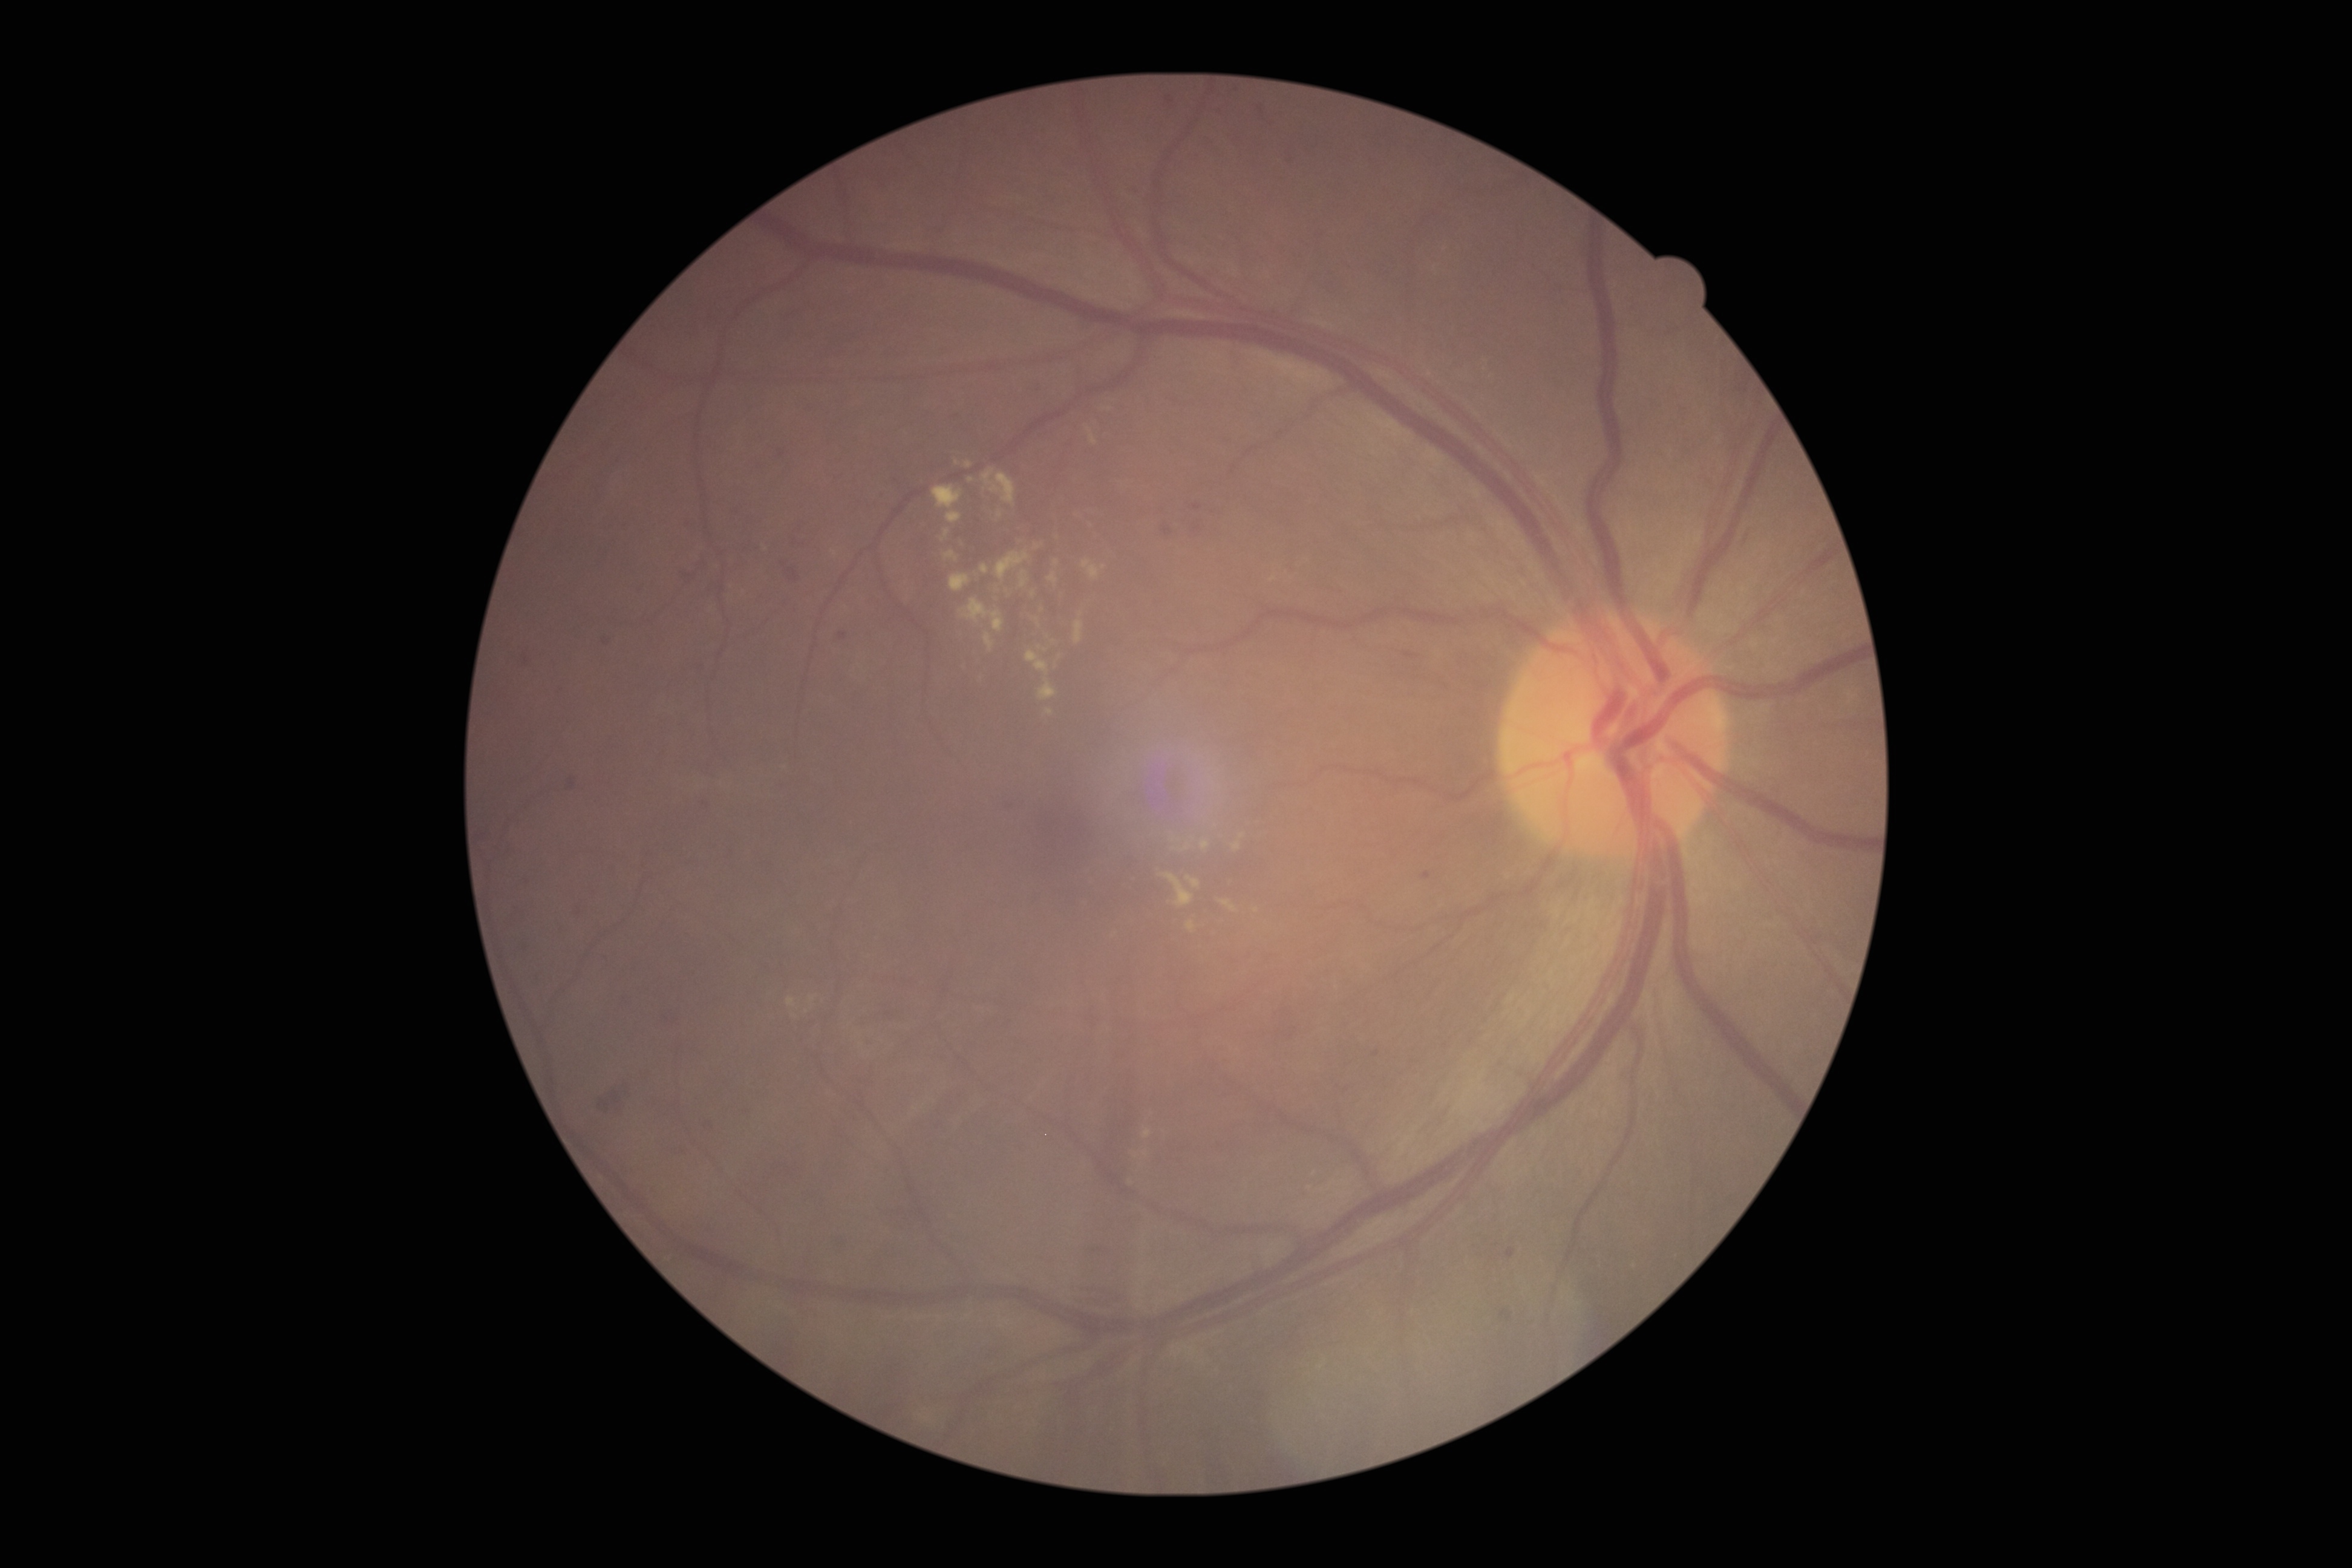

DR: moderate NPDR (grade 2)
Lesions identified (partial list):
MAs (more not shown) = [x1=704, y1=1121, x2=714, y2=1131] | [x1=486, y1=901, x2=492, y2=916] | [x1=477, y1=831, x2=487, y2=845] | [x1=1186, y1=501, x2=1204, y2=514] | [x1=792, y1=539, x2=806, y2=547] | [x1=1005, y1=803, x2=1014, y2=810] | [x1=780, y1=561, x2=800, y2=584] | [x1=1504, y1=1248, x2=1517, y2=1260] | [x1=777, y1=449, x2=787, y2=459] | [x1=1161, y1=523, x2=1174, y2=538] | [x1=577, y1=907, x2=583, y2=916] | [x1=1500, y1=1310, x2=1513, y2=1323]
Smaller MAs around <pt>525,949</pt> | <pt>1220,1147</pt> | <pt>1221,114</pt> | <pt>688,525</pt>
HEs (more not shown) = [x1=699, y1=562, x2=707, y2=570] | [x1=855, y1=1091, x2=866, y2=1112] | [x1=1402, y1=653, x2=1421, y2=660] | [x1=1088, y1=1247, x2=1111, y2=1256] | [x1=1277, y1=1028, x2=1298, y2=1042] | [x1=681, y1=573, x2=697, y2=585] | [x1=597, y1=1083, x2=630, y2=1116] | [x1=1279, y1=1008, x2=1293, y2=1023] | [x1=773, y1=1163, x2=799, y2=1178]
SEs = not present
EXs (more not shown) = [x1=942, y1=529, x2=950, y2=543] | [x1=949, y1=574, x2=972, y2=592] | [x1=995, y1=552, x2=1030, y2=581] | [x1=944, y1=552, x2=958, y2=562] | [x1=1046, y1=710, x2=1054, y2=717] | [x1=1036, y1=619, x2=1041, y2=627] | [x1=1075, y1=621, x2=1083, y2=645] | [x1=959, y1=599, x2=1004, y2=632] | [x1=981, y1=564, x2=989, y2=574] | [x1=1186, y1=877, x2=1202, y2=889]
Smaller EXs around <pt>813,1000</pt> | <pt>1037,547</pt> | <pt>1256,911</pt> | <pt>957,463</pt>